50° field of view — 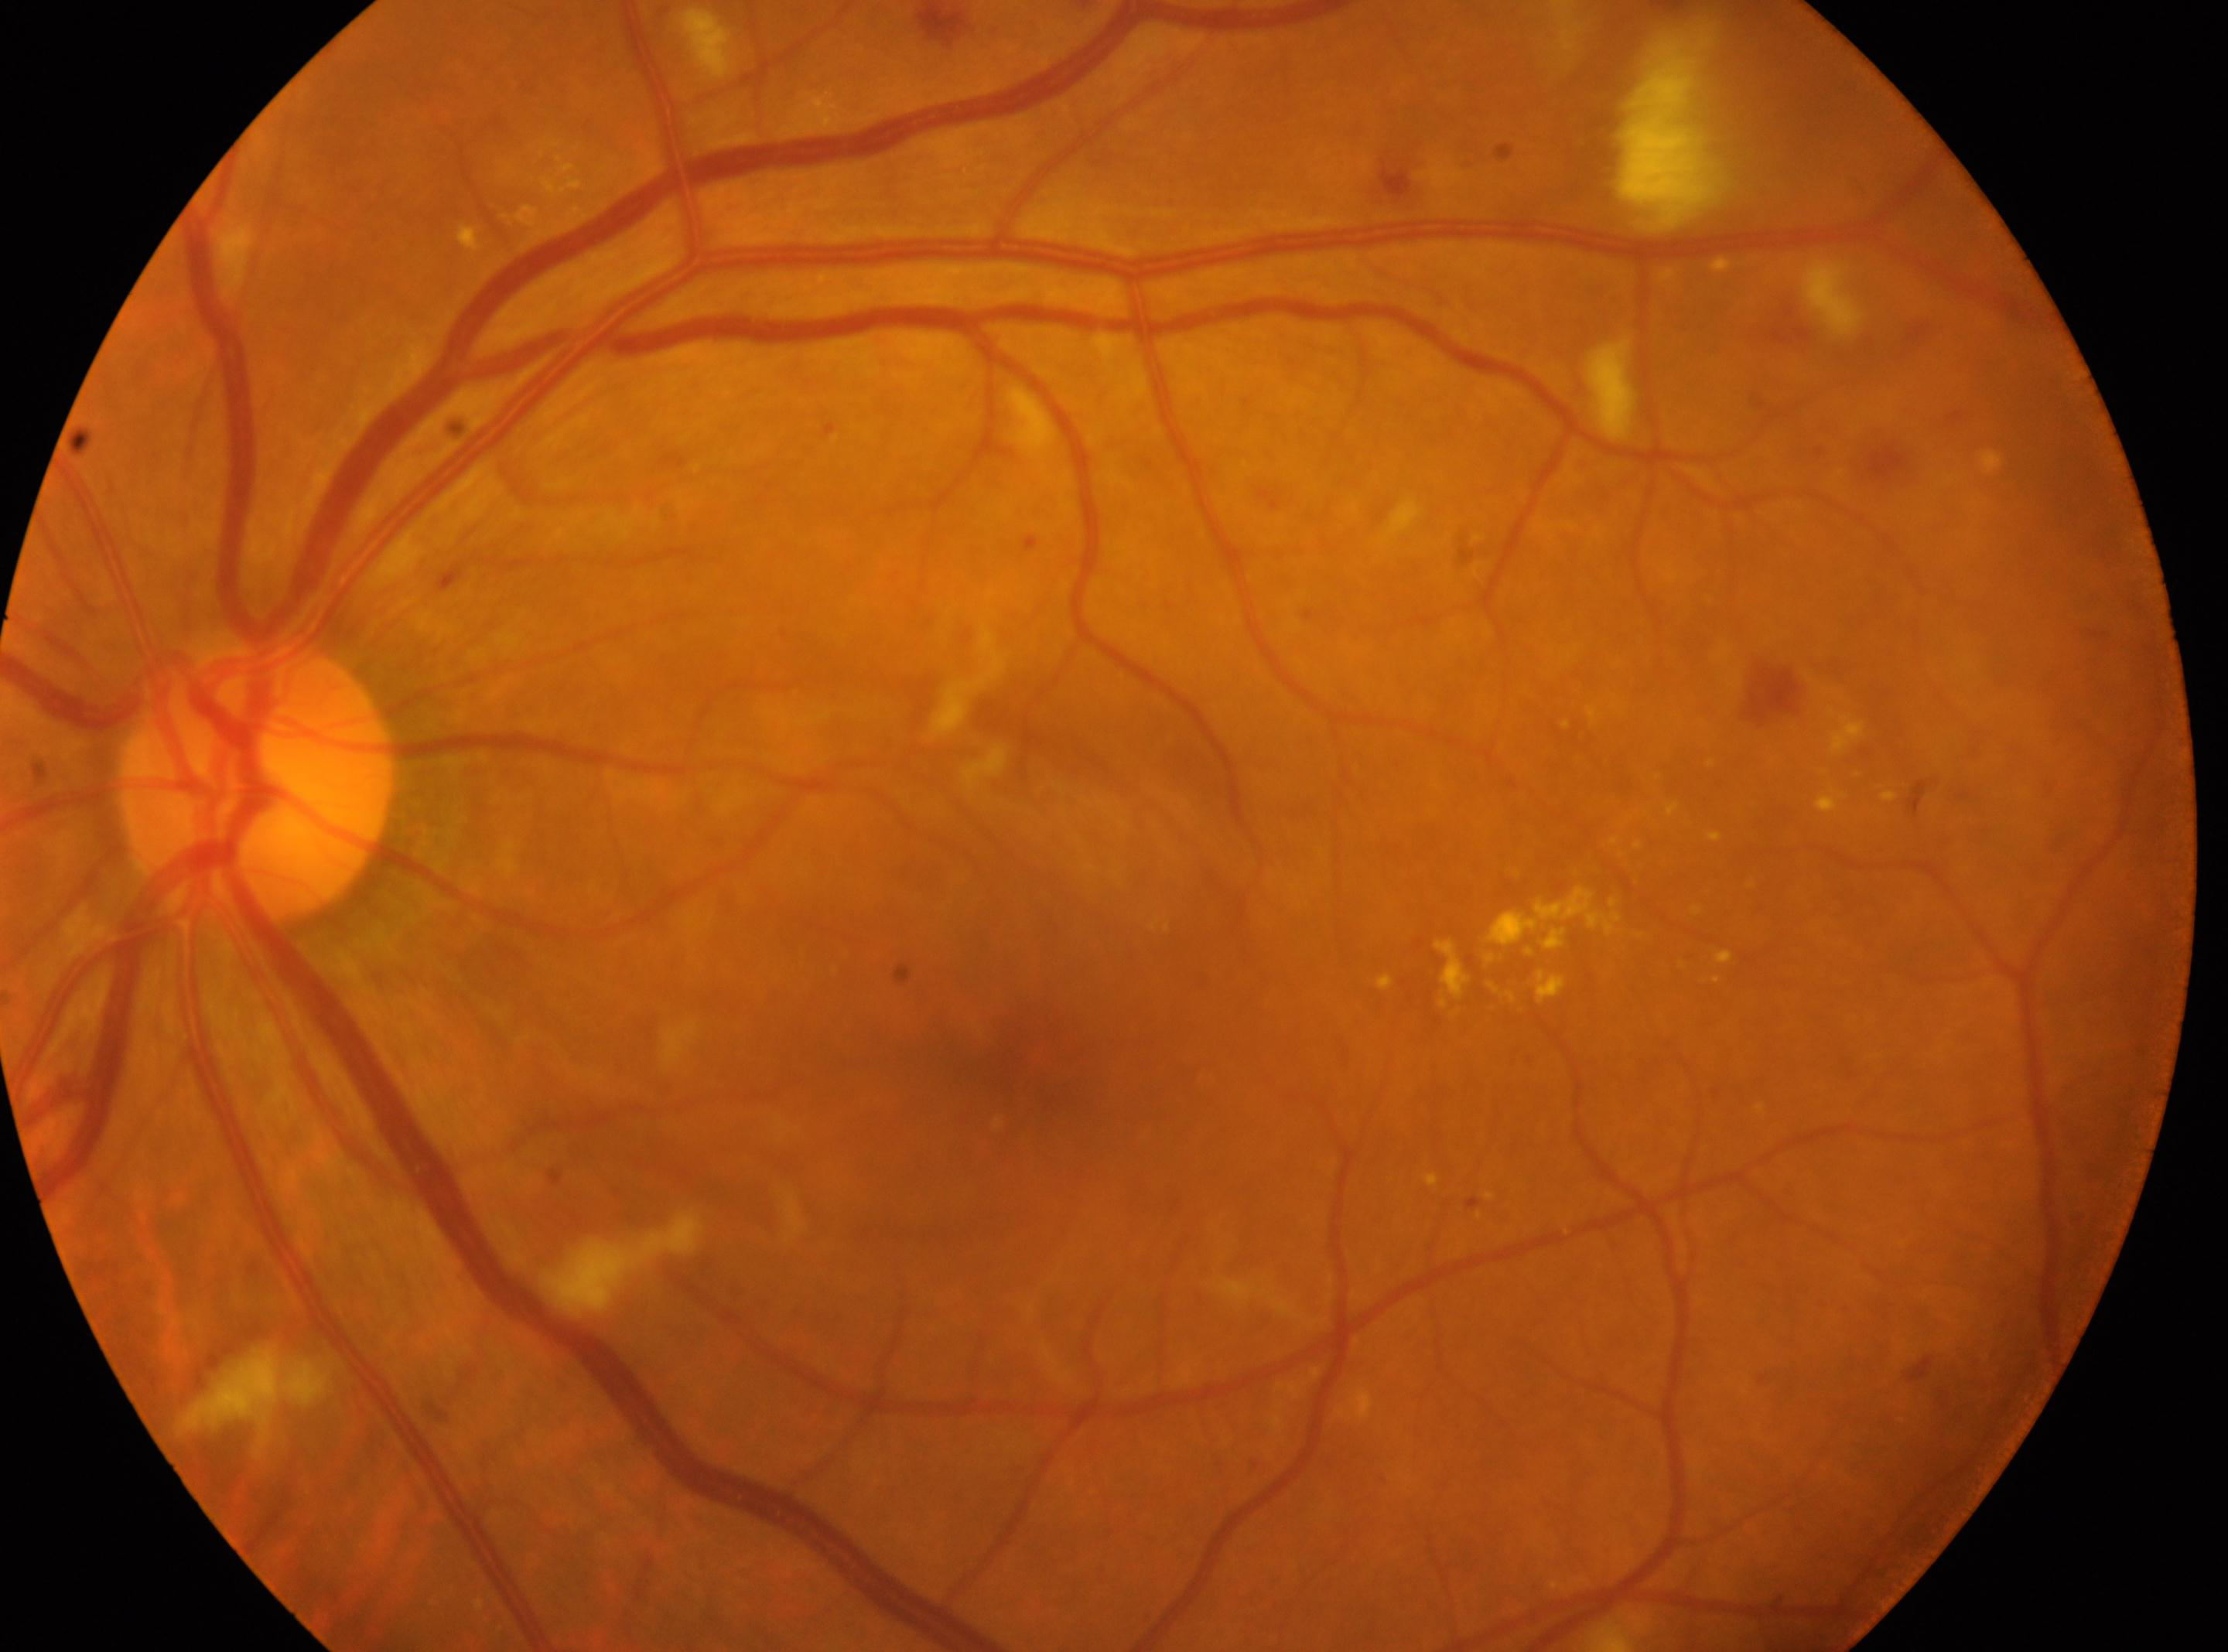

Imaged eye: left eye.
DR severity: grade 2 (moderate NPDR).
Optic disc: (x: 254, y: 786).
Fovea located at (x: 1026, y: 1078).